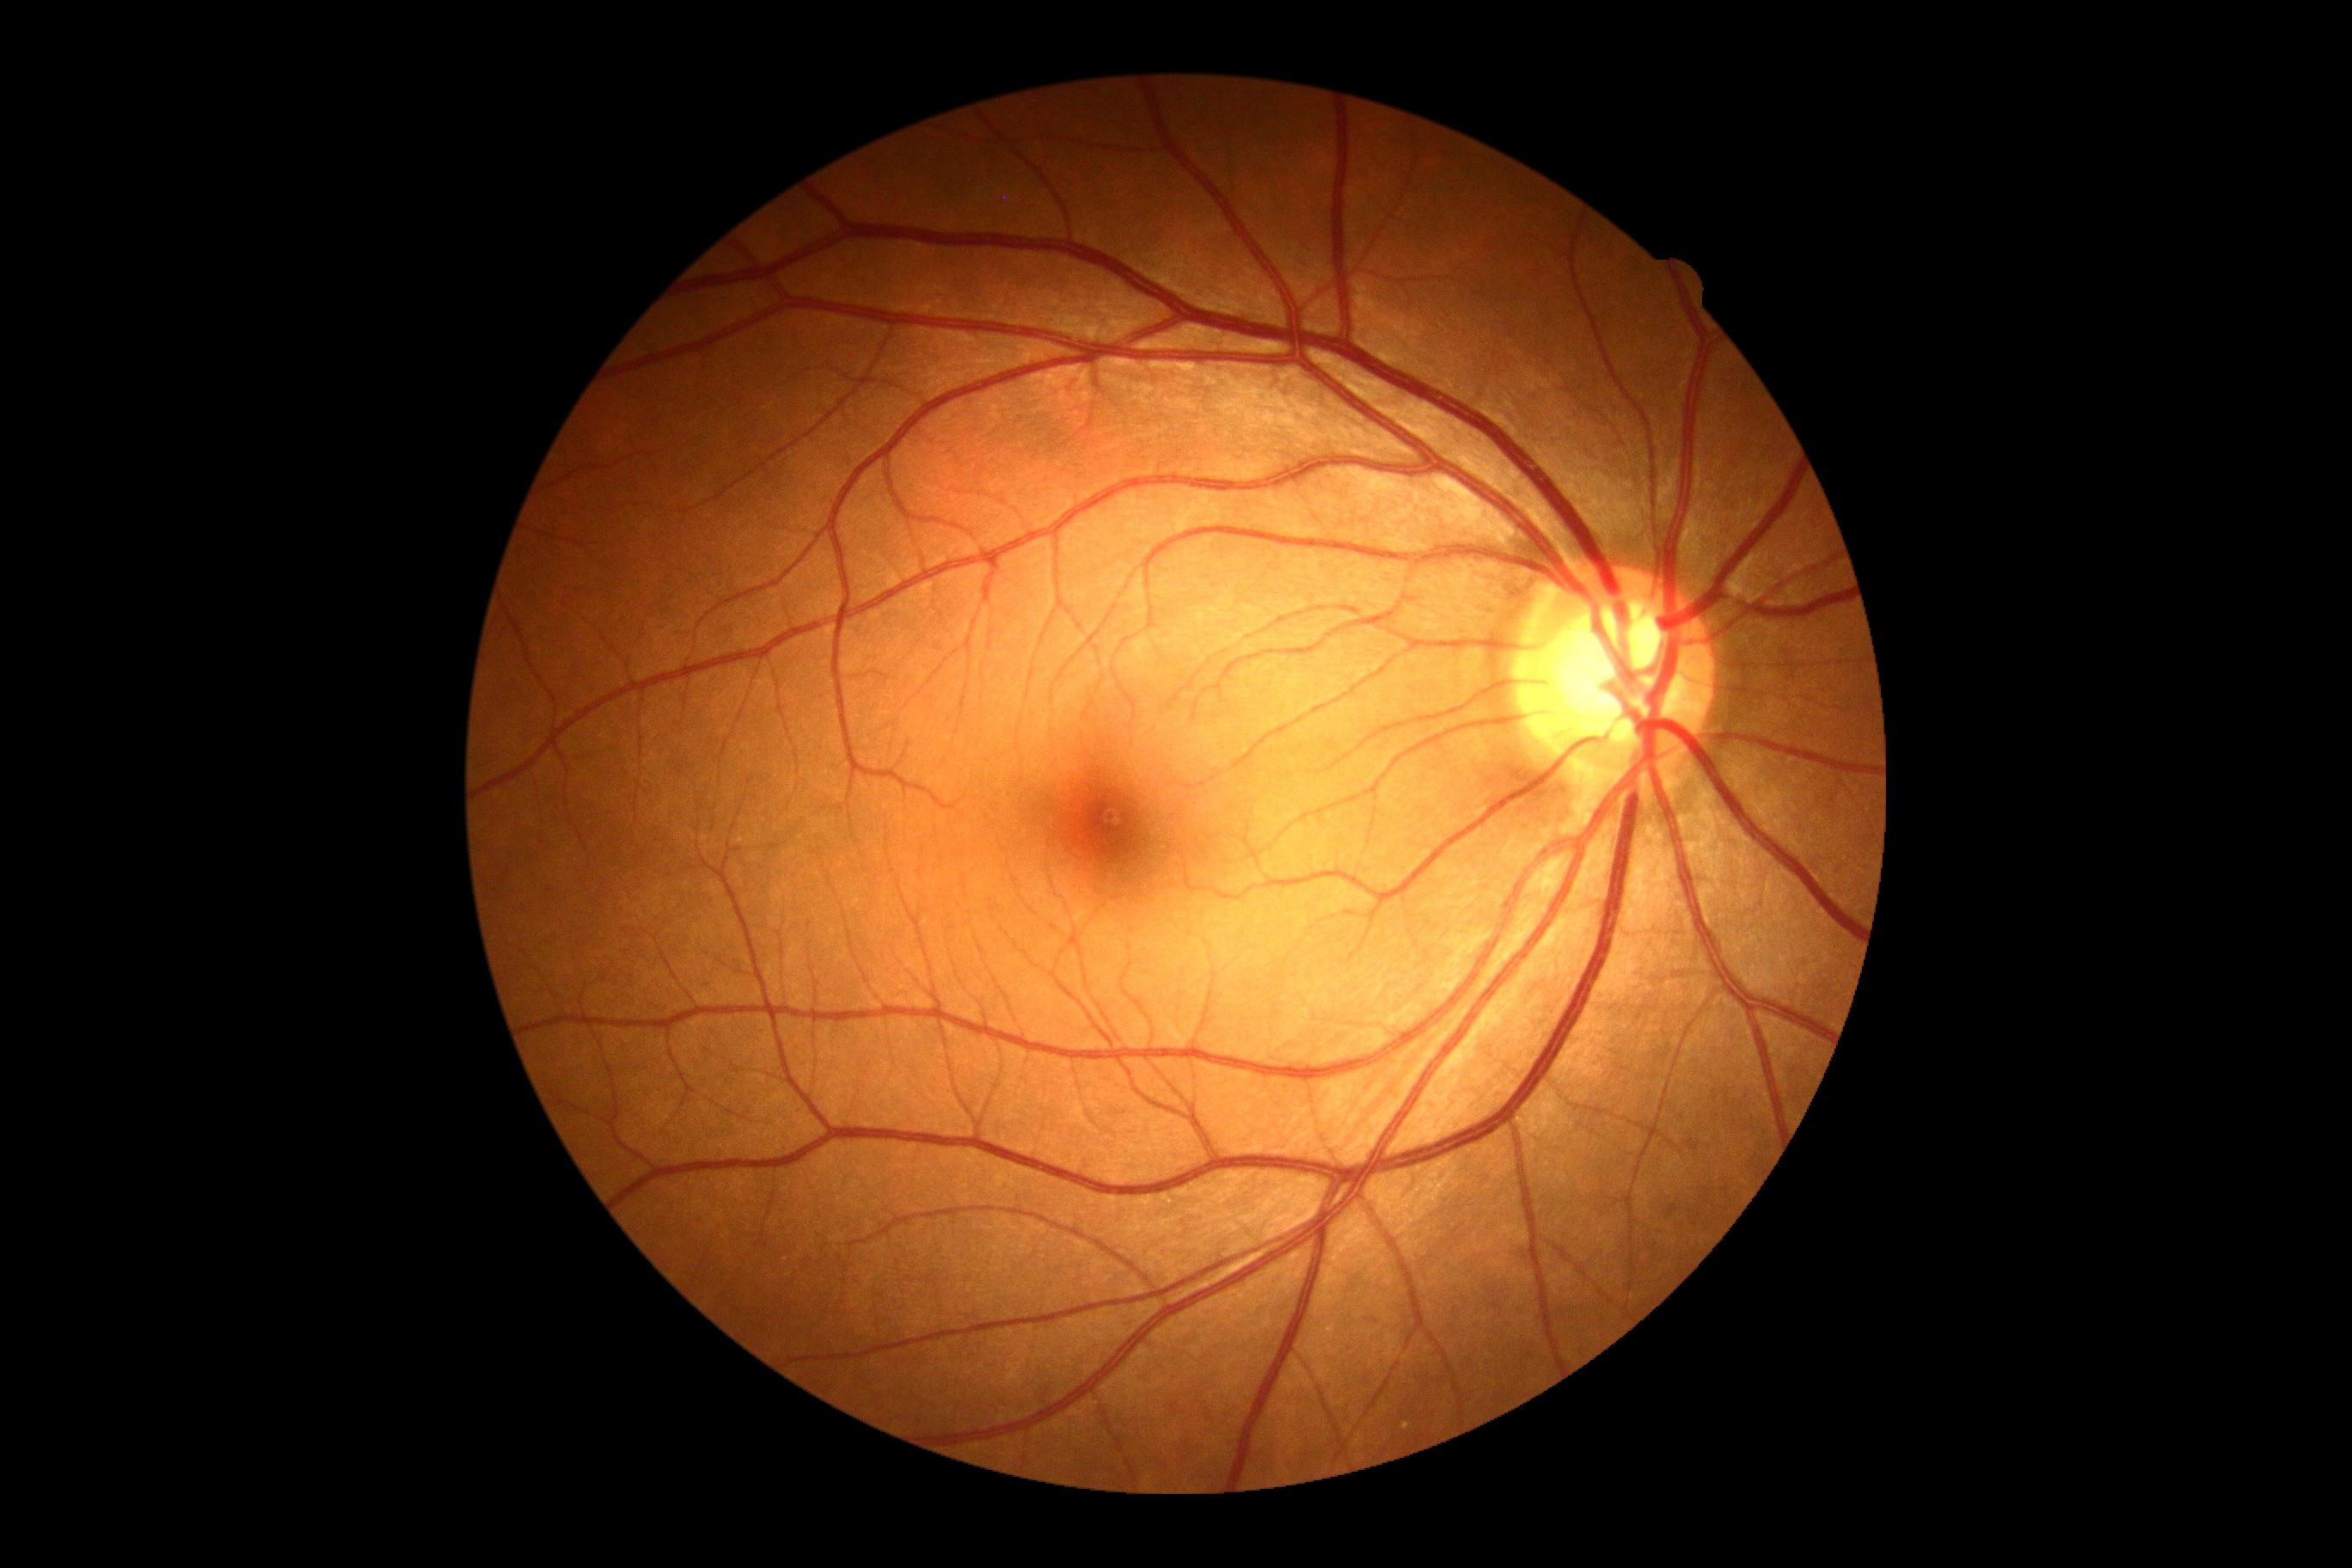
Findings:
• DR stage: grade 0 (no apparent retinopathy)